Captured on a Remidio Fundus on Phone, retinal fundus photograph — 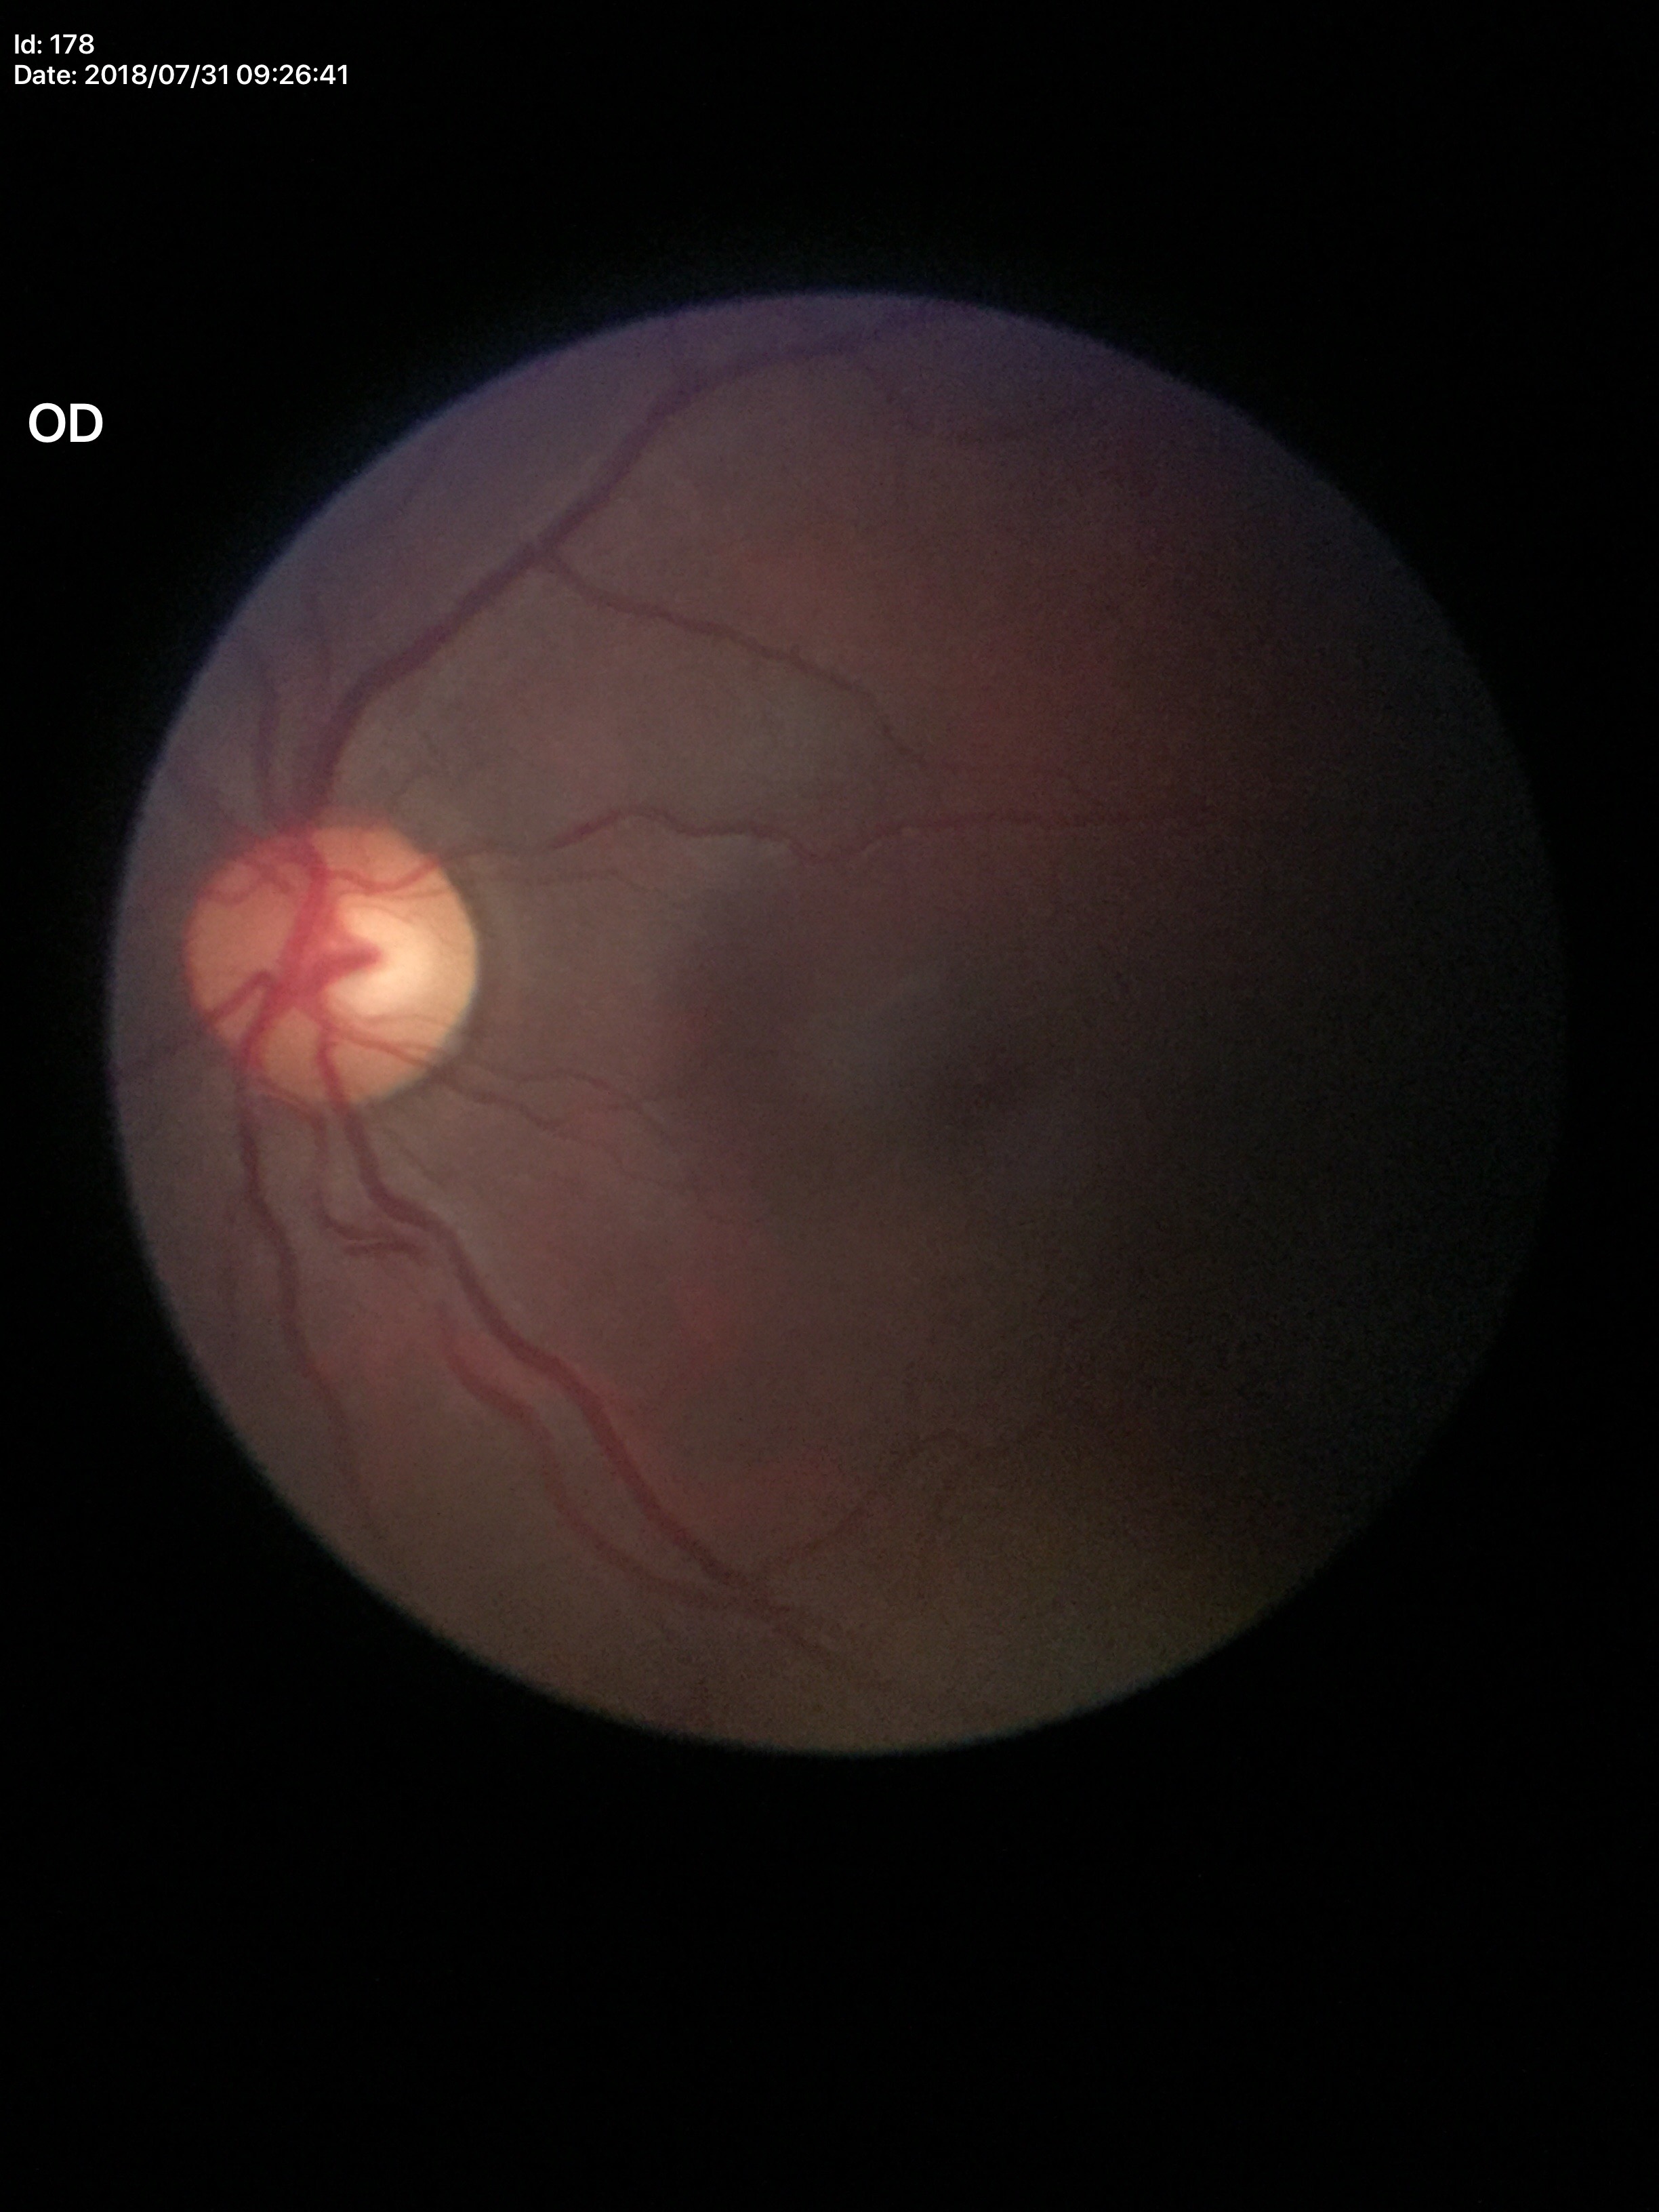 Glaucoma evaluation: no suspicious findings.
Vertical cup-disc ratio is 0.55.